Fundus image cropped to the optic disc:
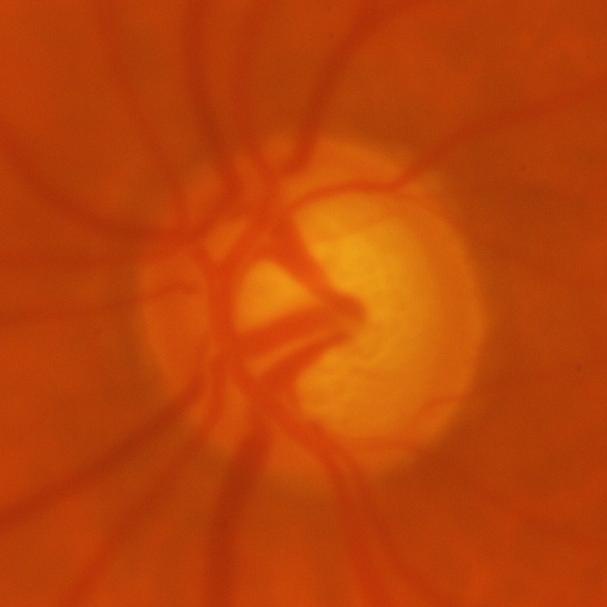

Q: What is the glaucoma diagnosis?
A: Glaucomatous optic neuropathy.